Wide-field fundus photograph from neonatal ROP screening: 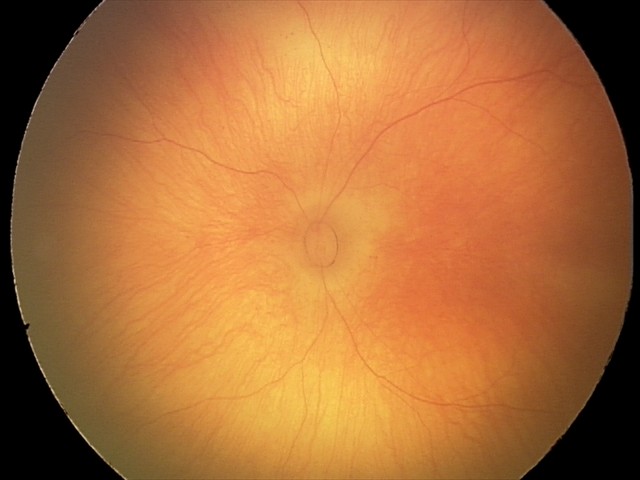
Screening examination diagnosed as physiological.